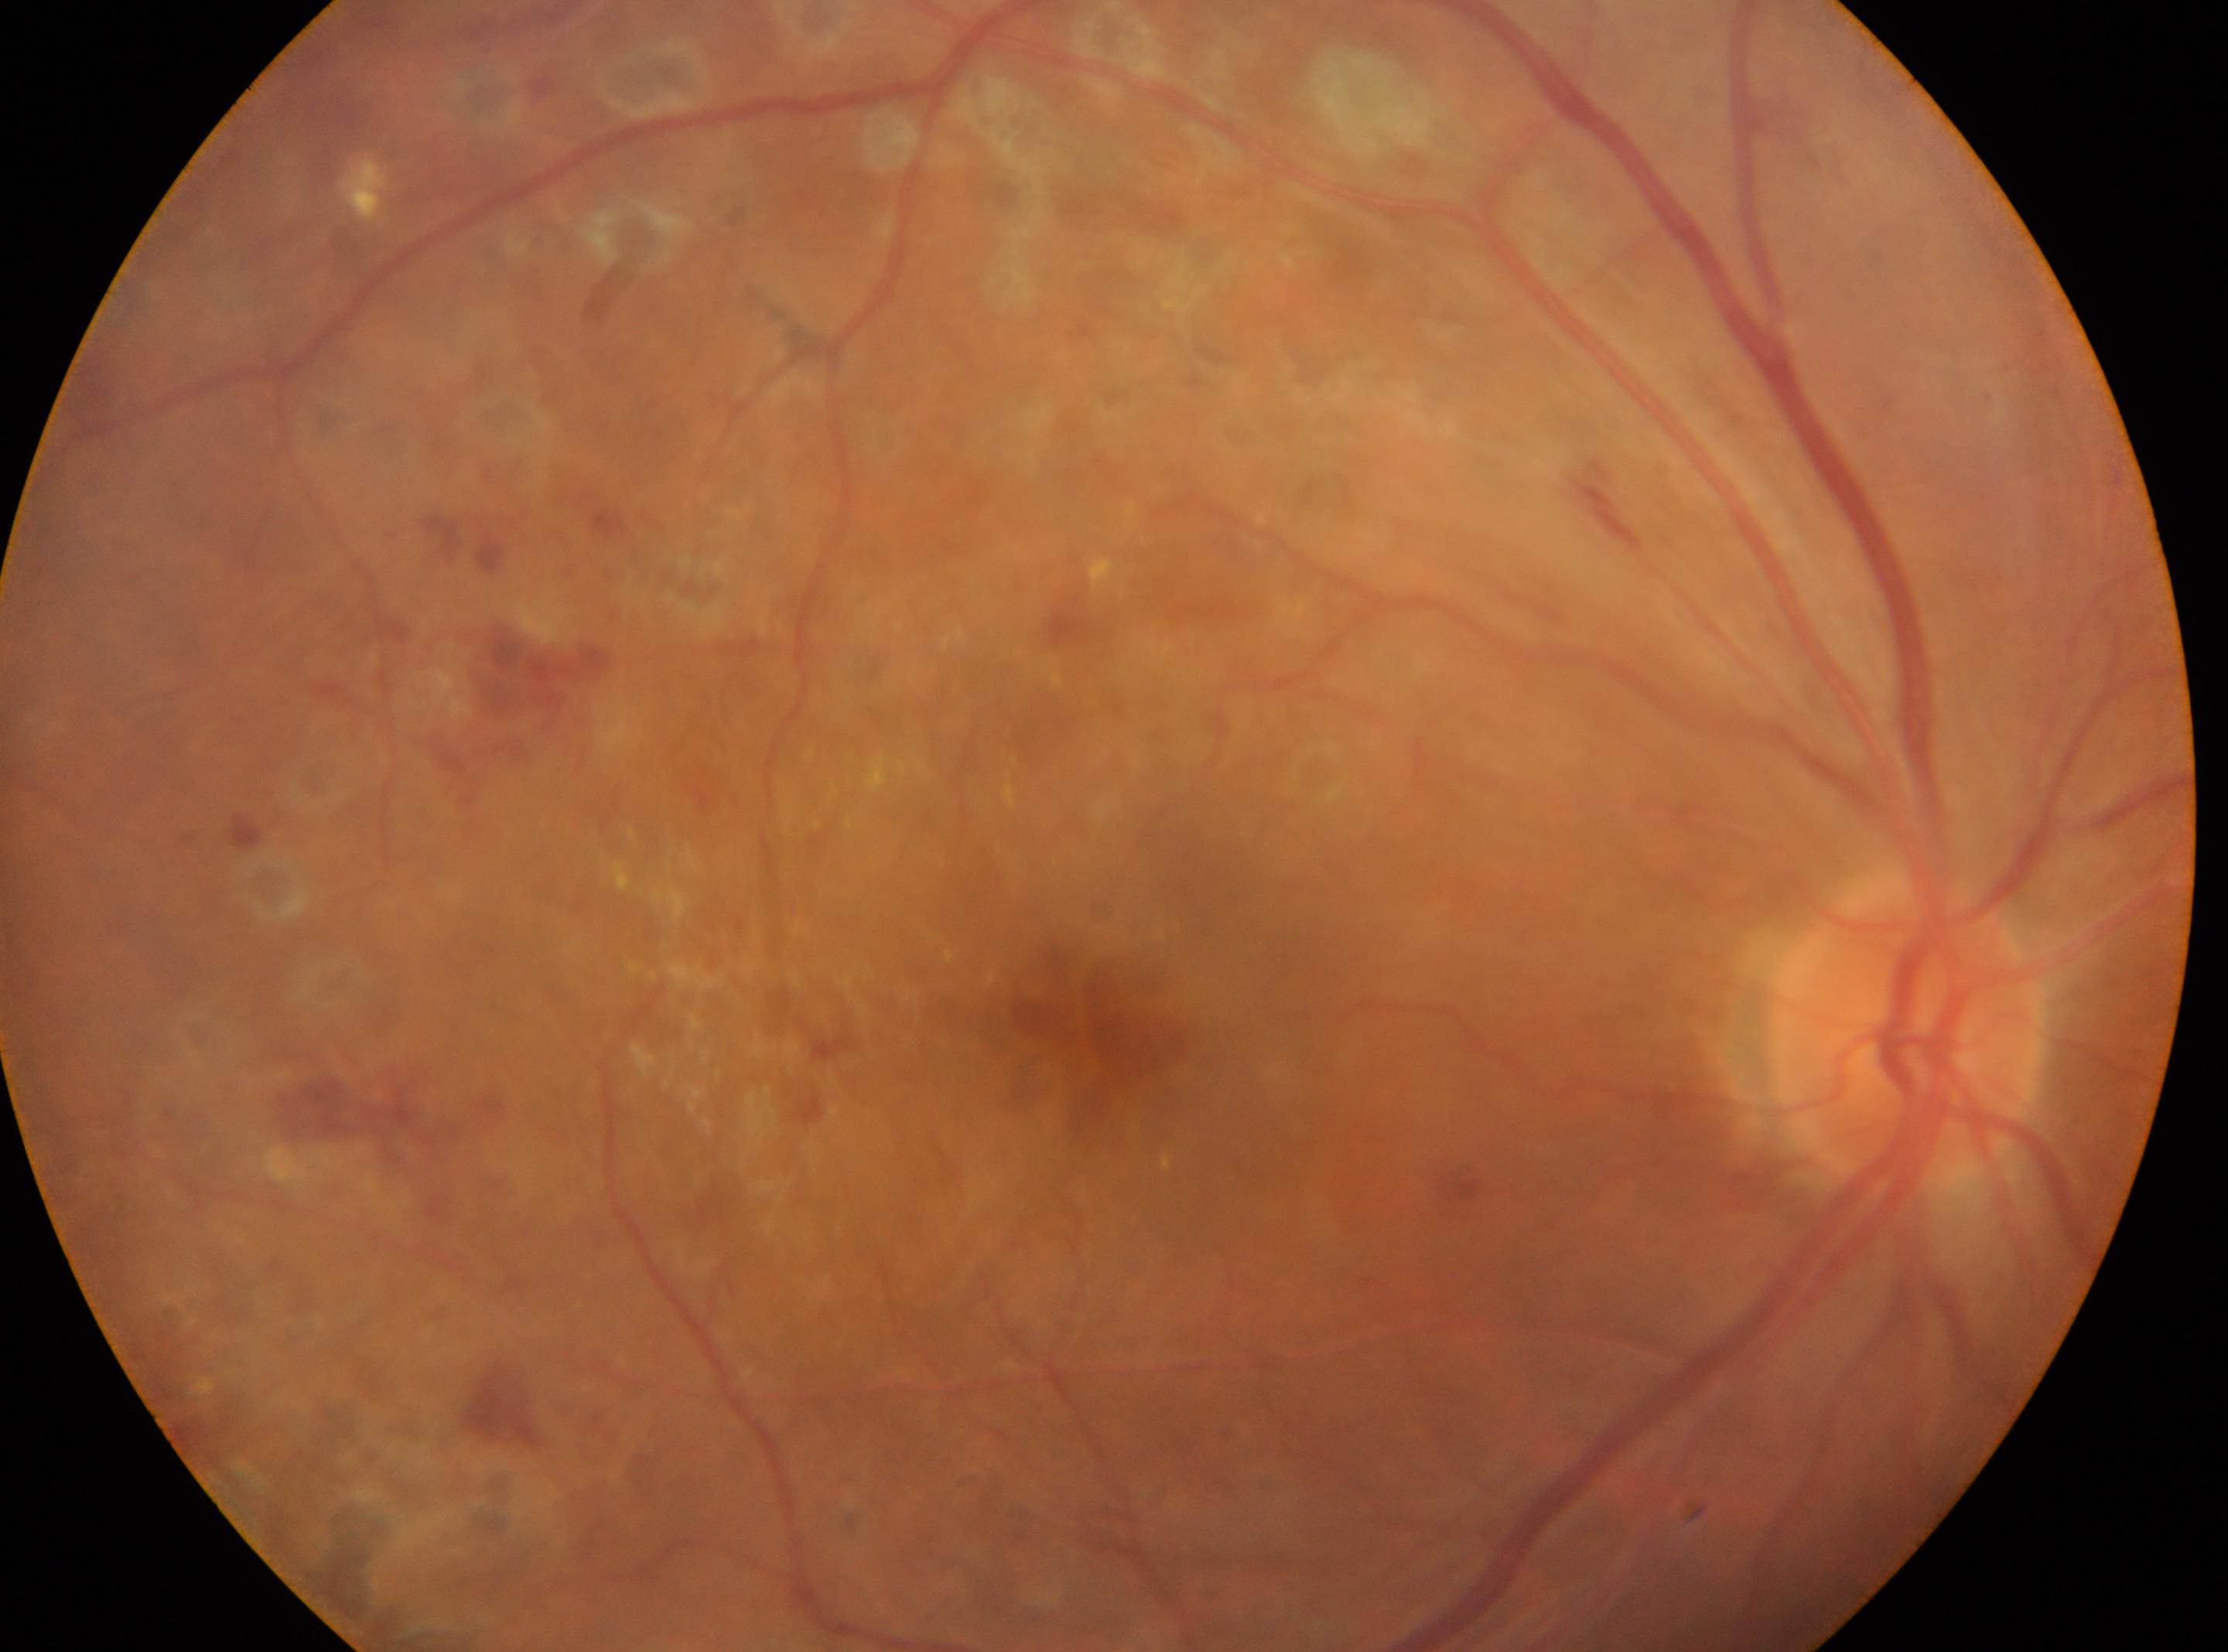 DR: DR with laser spots or scars, reclassified as PDR (grade 4).
Fovea centralis located at (x: 1078, y: 1019).
Imaged eye: oculus dexter.
The optic disc is at (x: 1903, y: 1032).